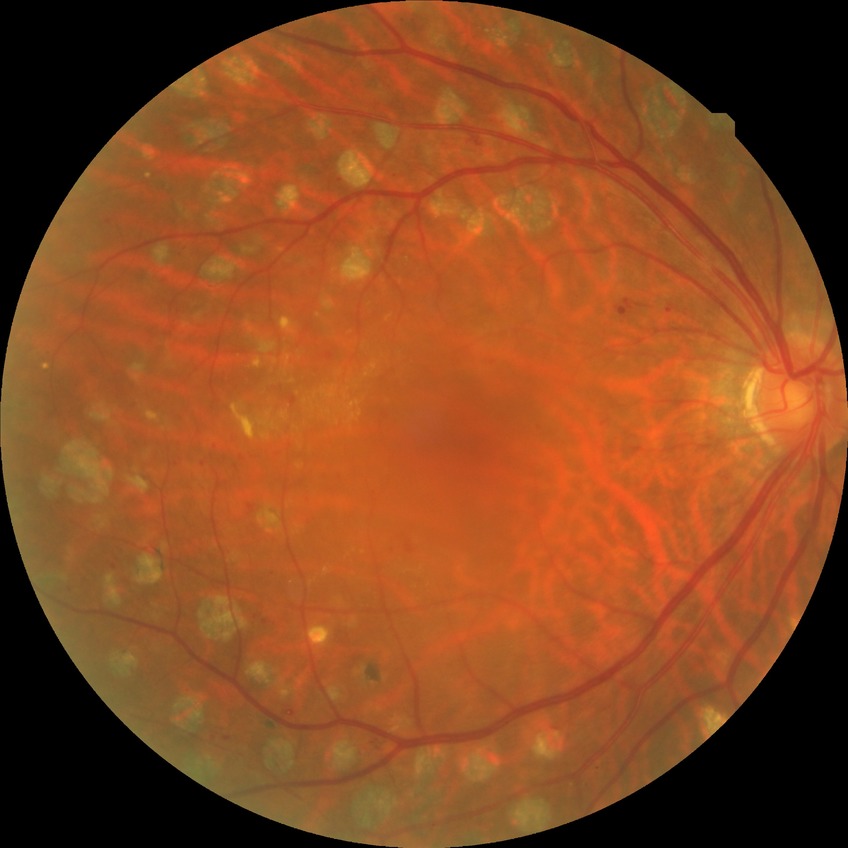

diabetic retinopathy (DR)@PDR (proliferative diabetic retinopathy).